Color fundus image: 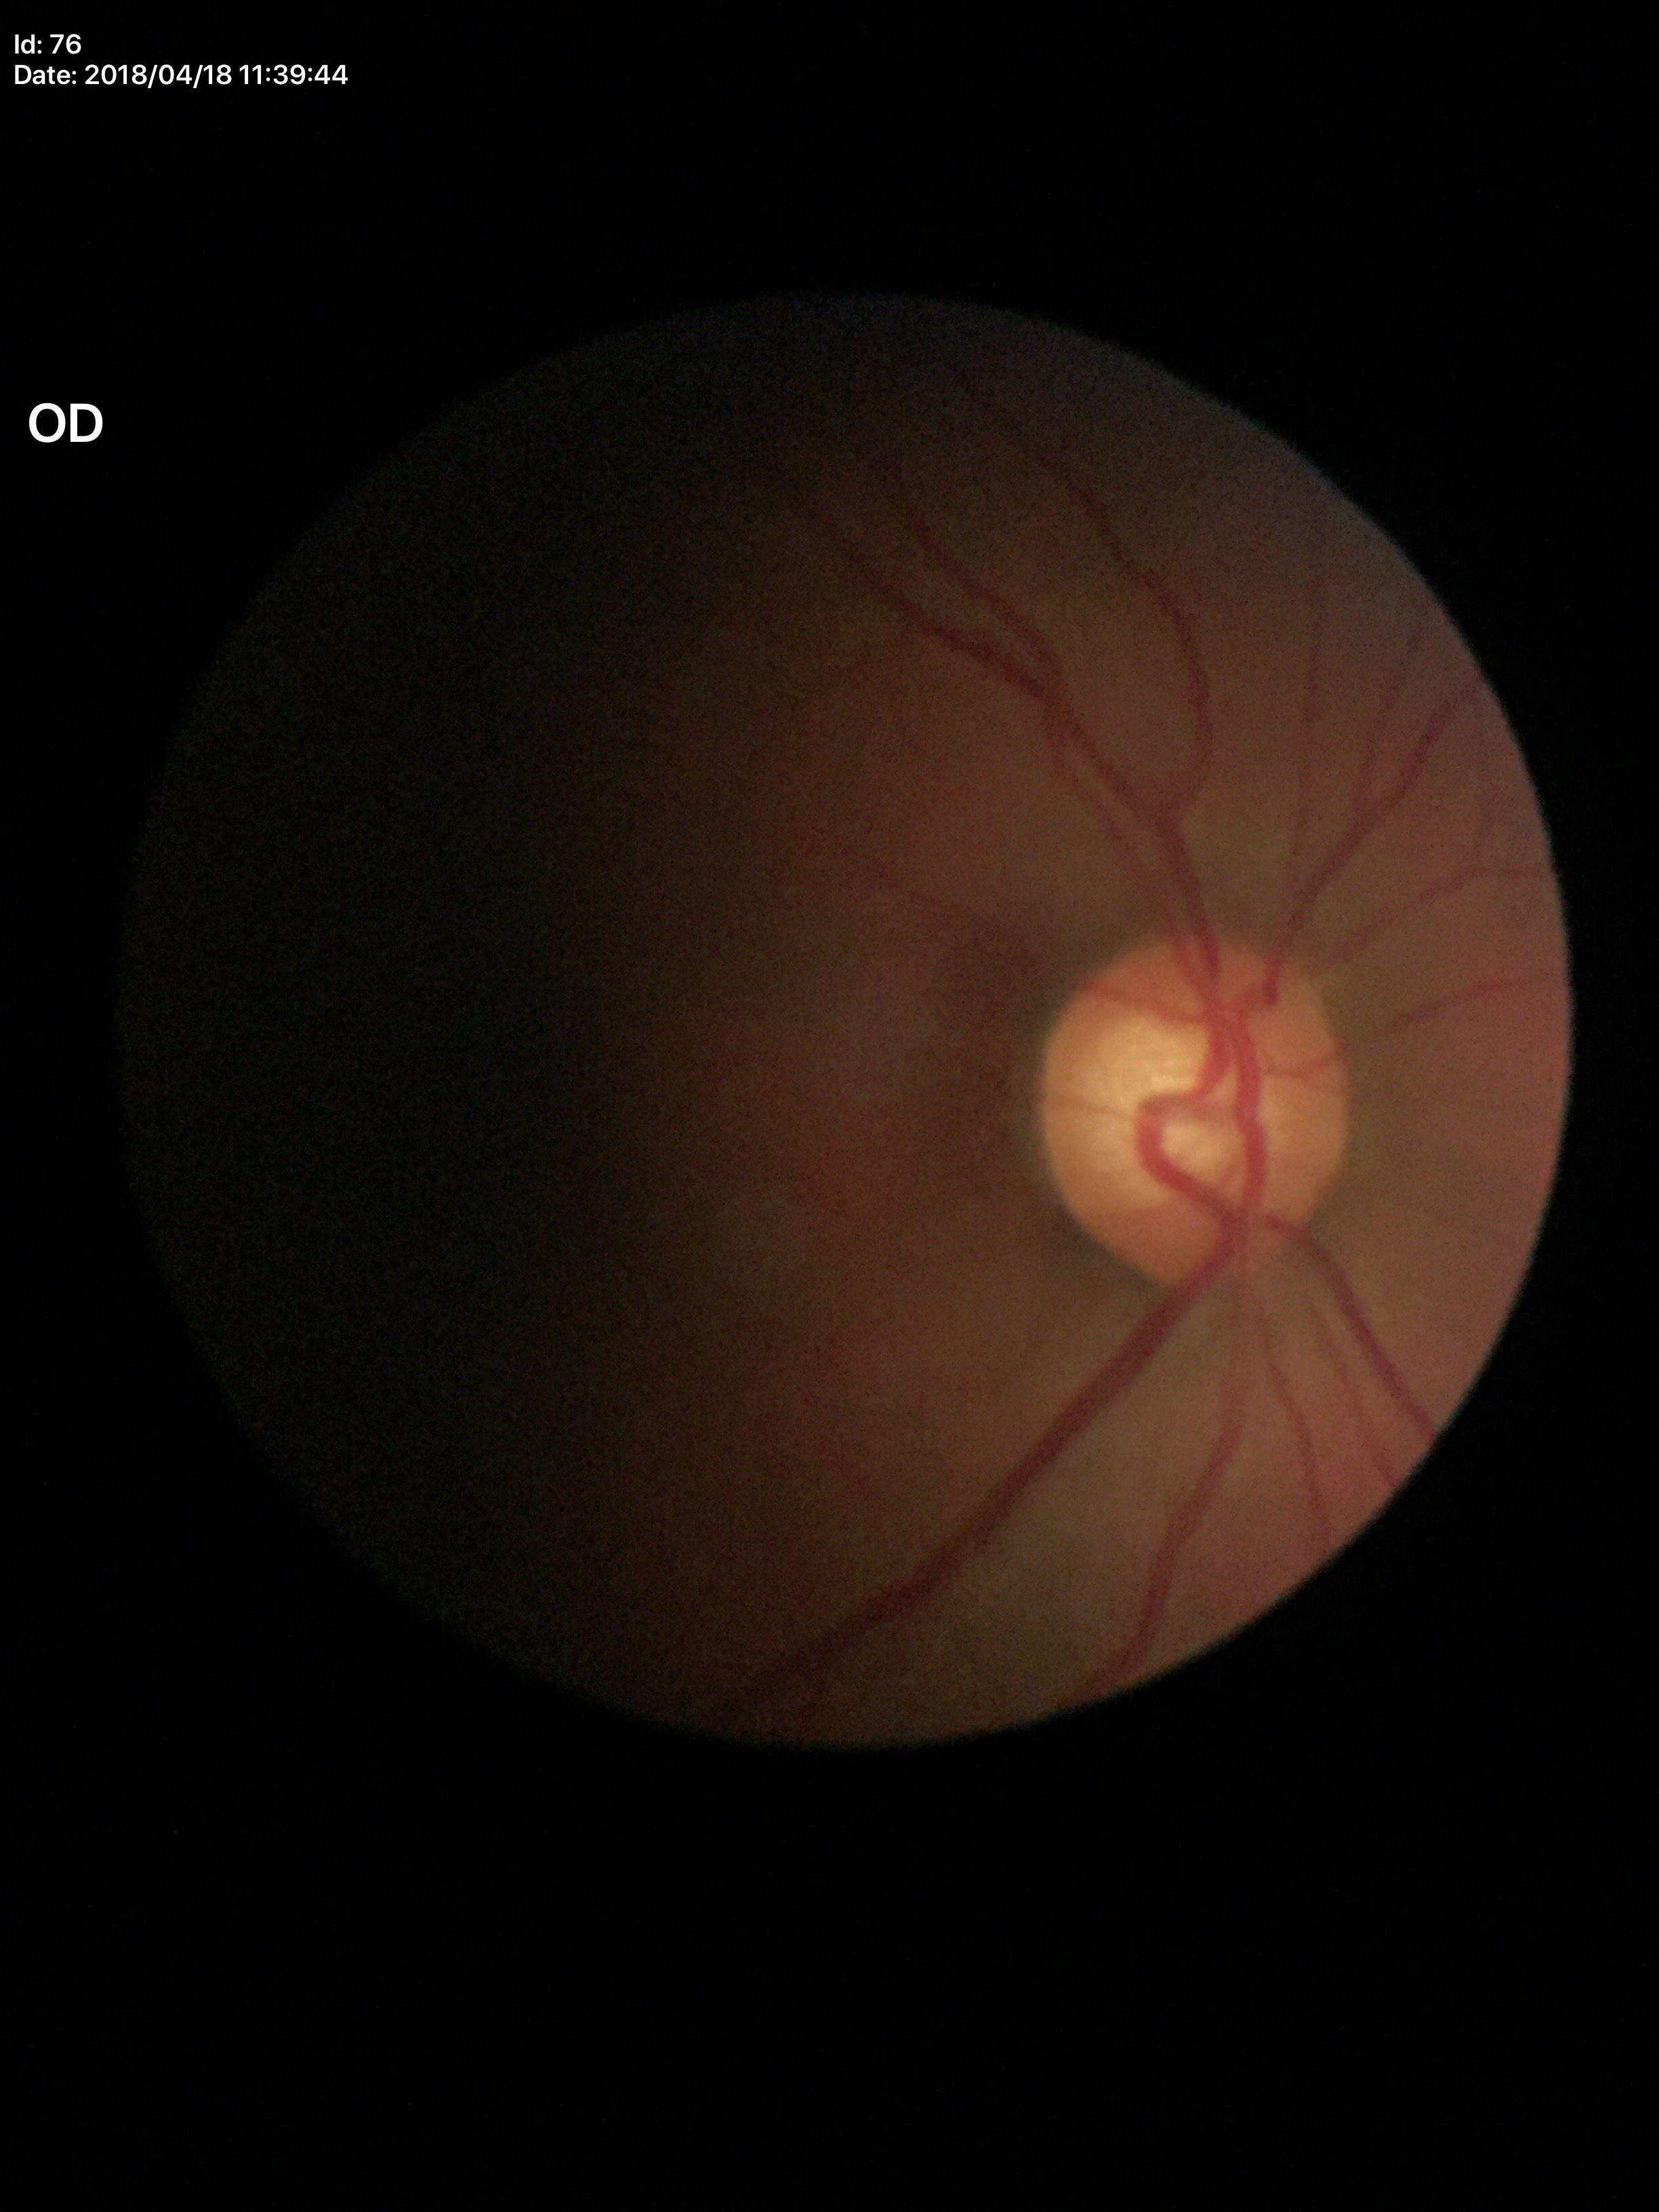
Annotations:
– HCDR — 0.64
– Glaucoma screening — negative
– VCDR — 0.59